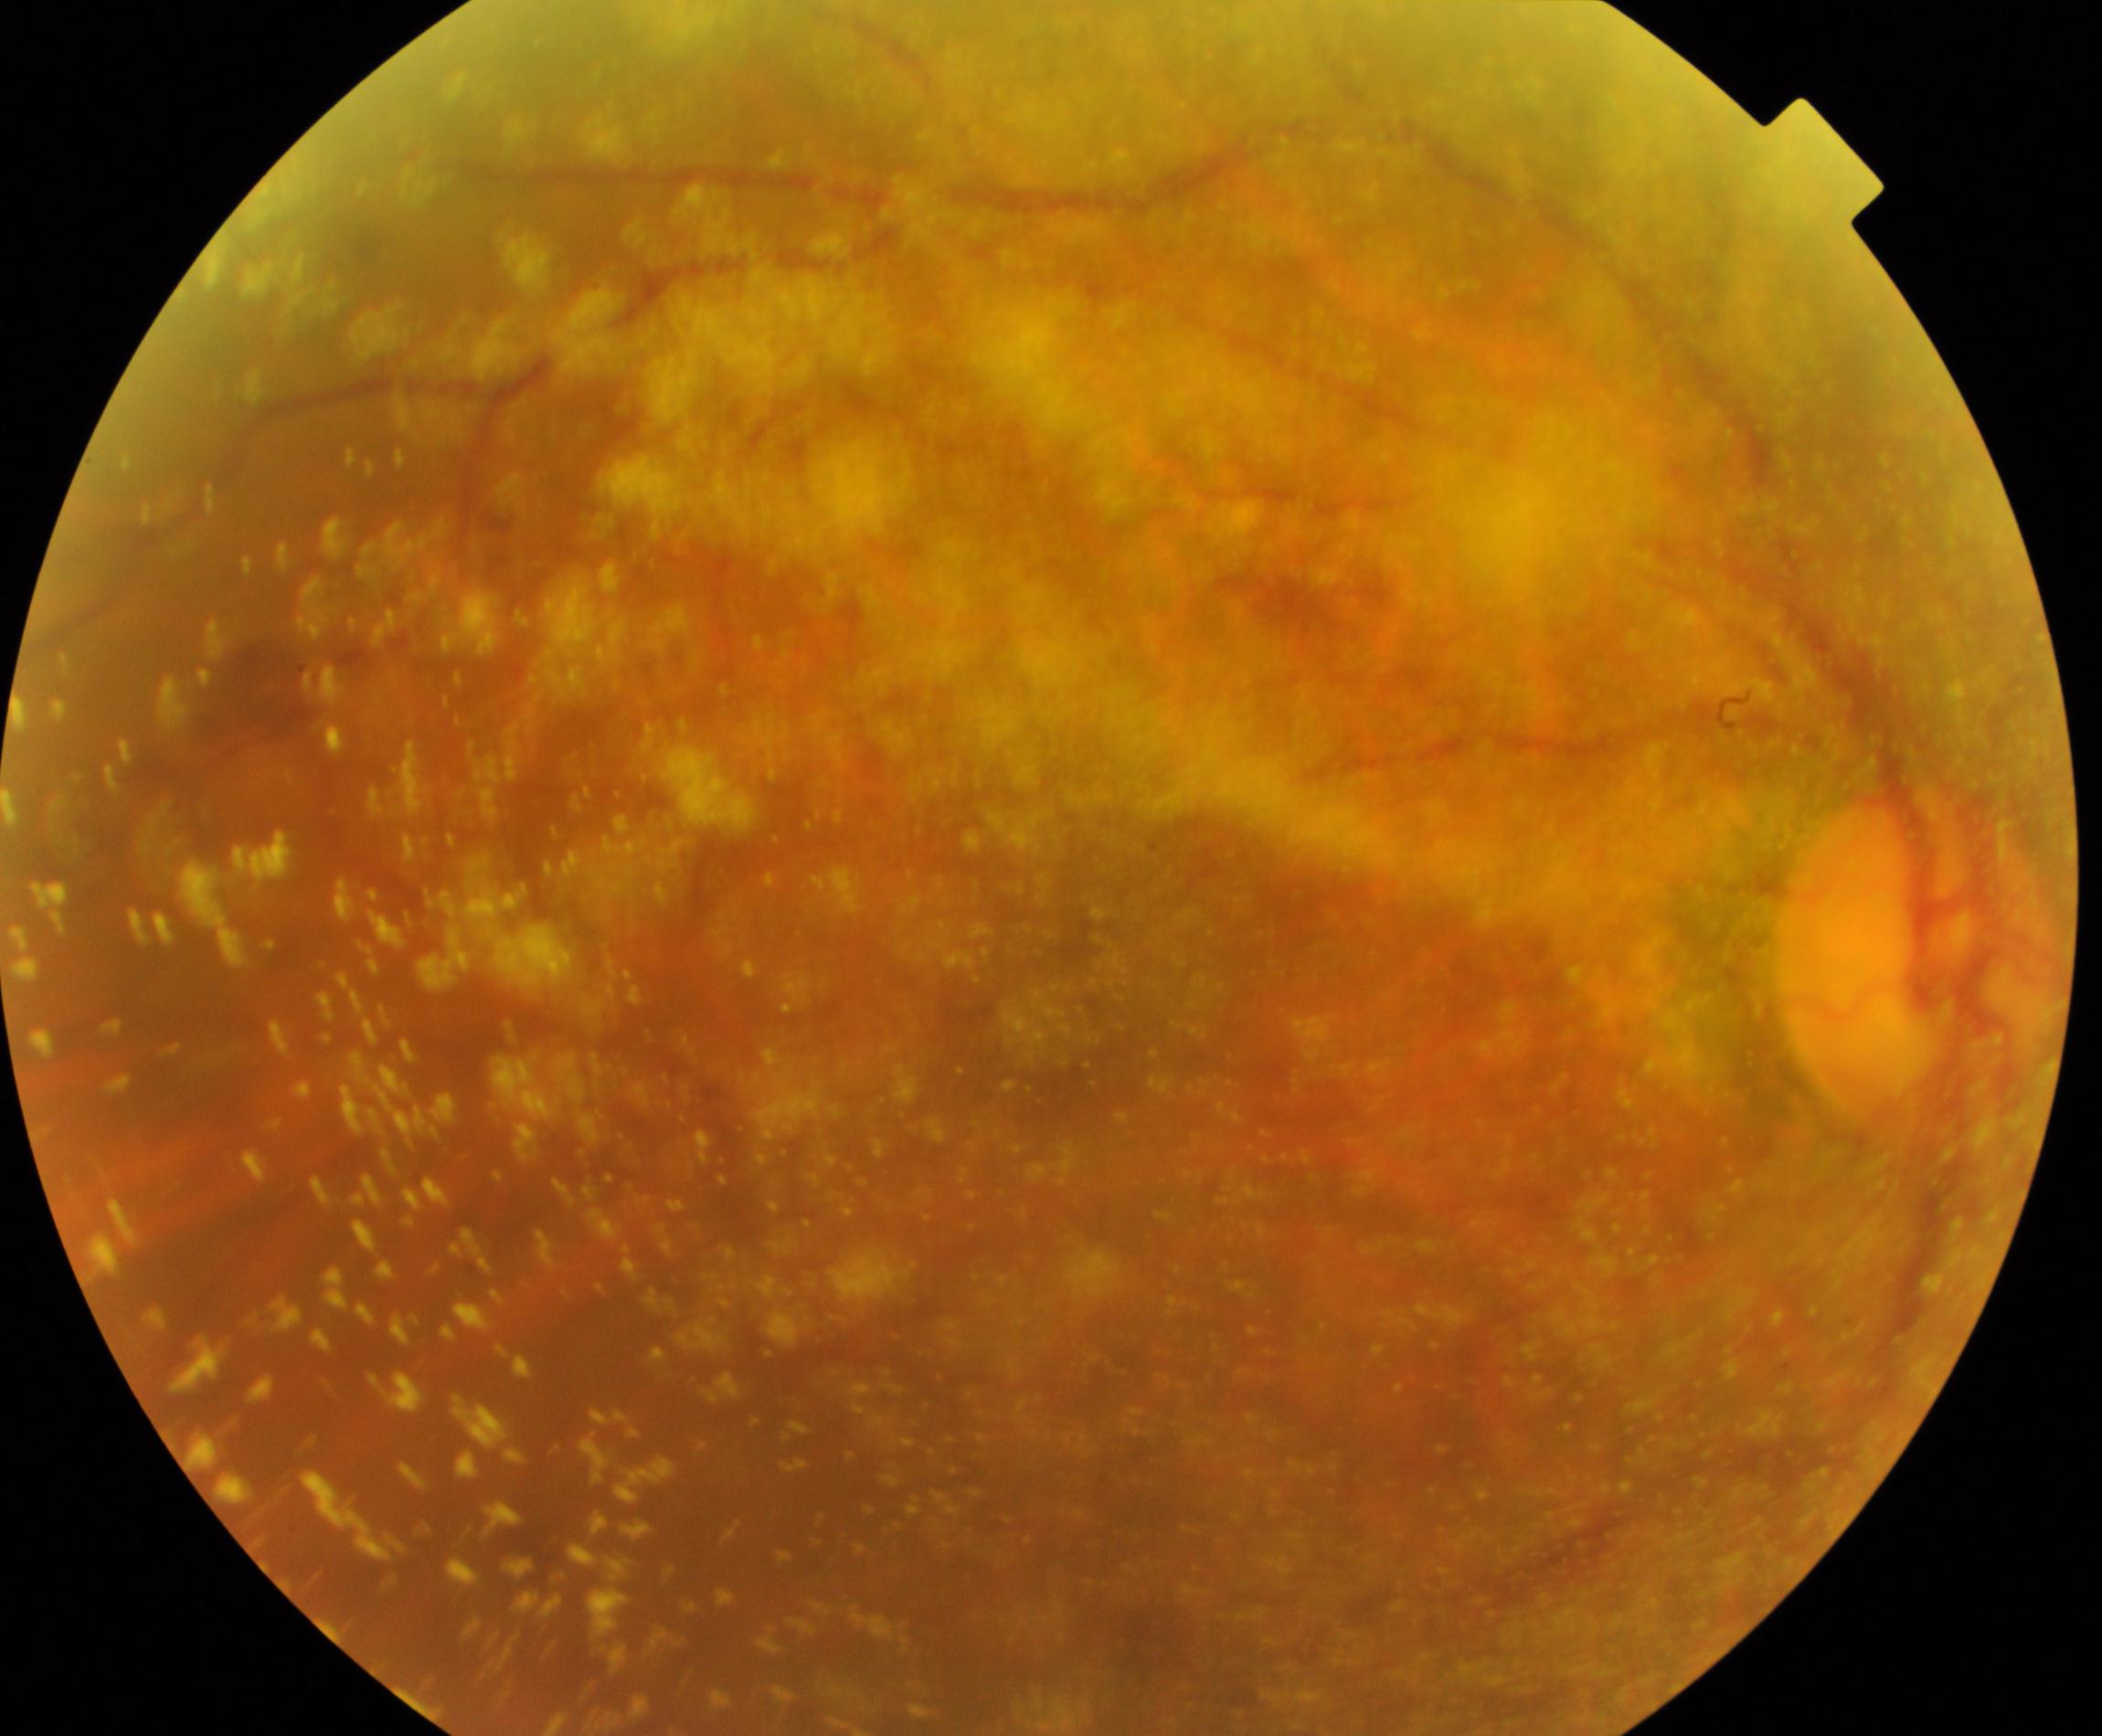
Impression: vitreous particles.